Modified Davis classification.
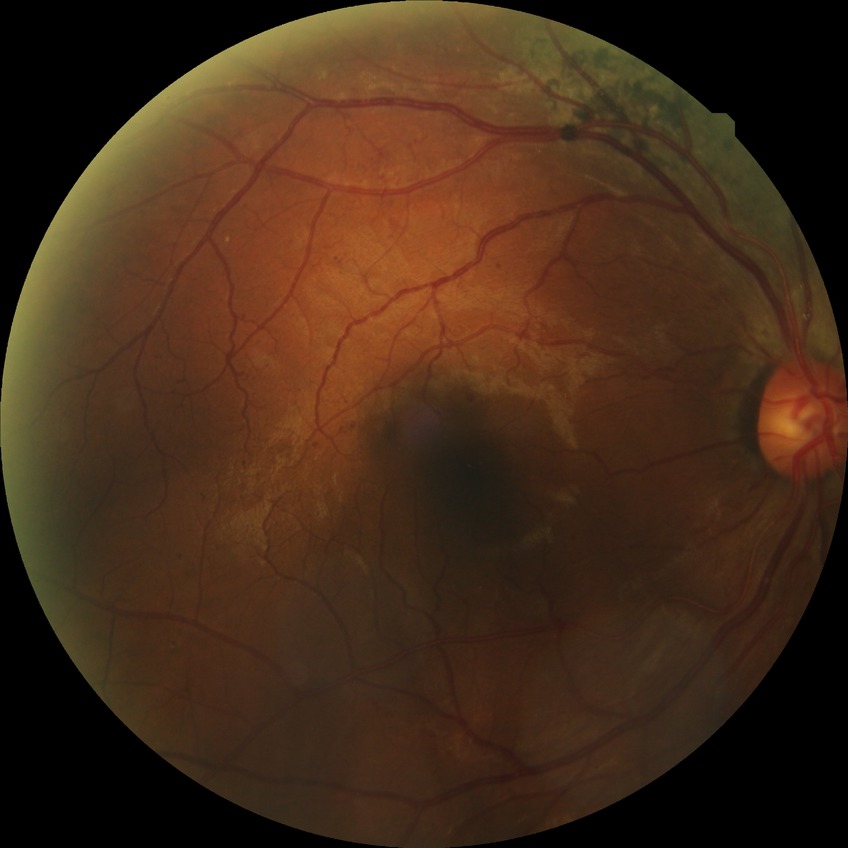 Retinopathy stage is pre-proliferative diabetic retinopathy. DR class: non-proliferative diabetic retinopathy.